Retinal fundus photograph, 2352x1568 — 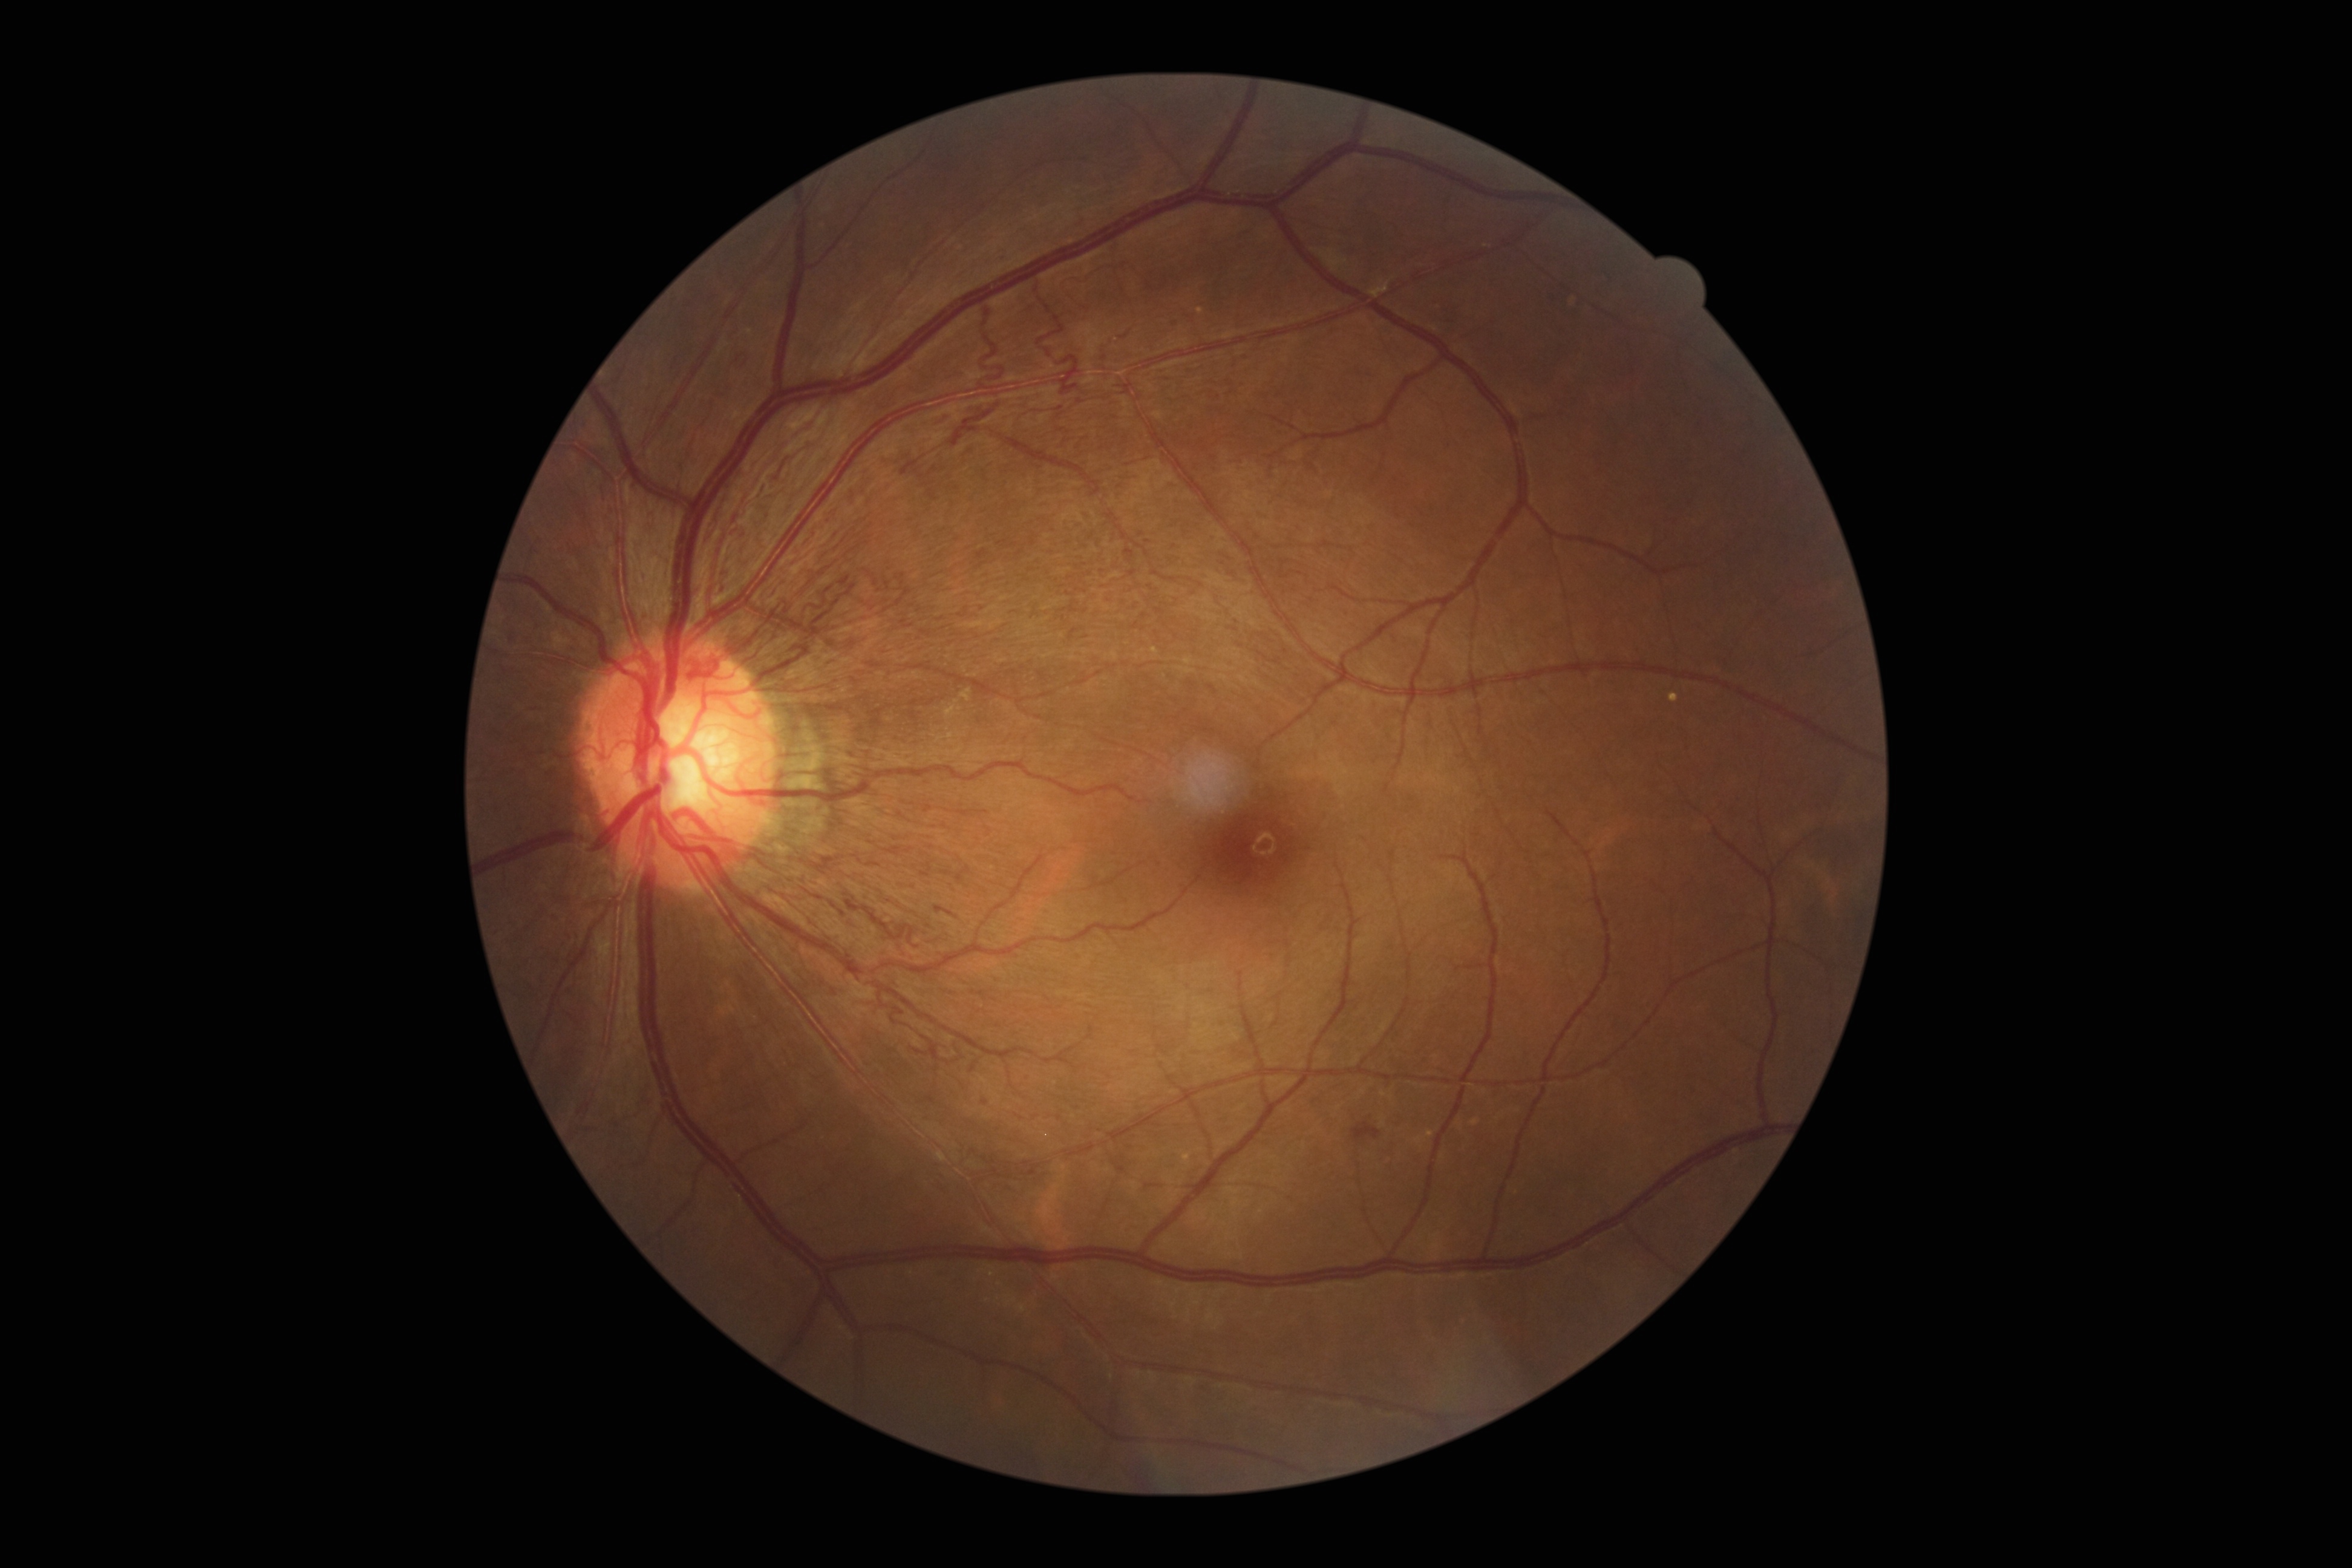

DR grade@4.